Color fundus photograph, 2352x1568px, 45° FOV: 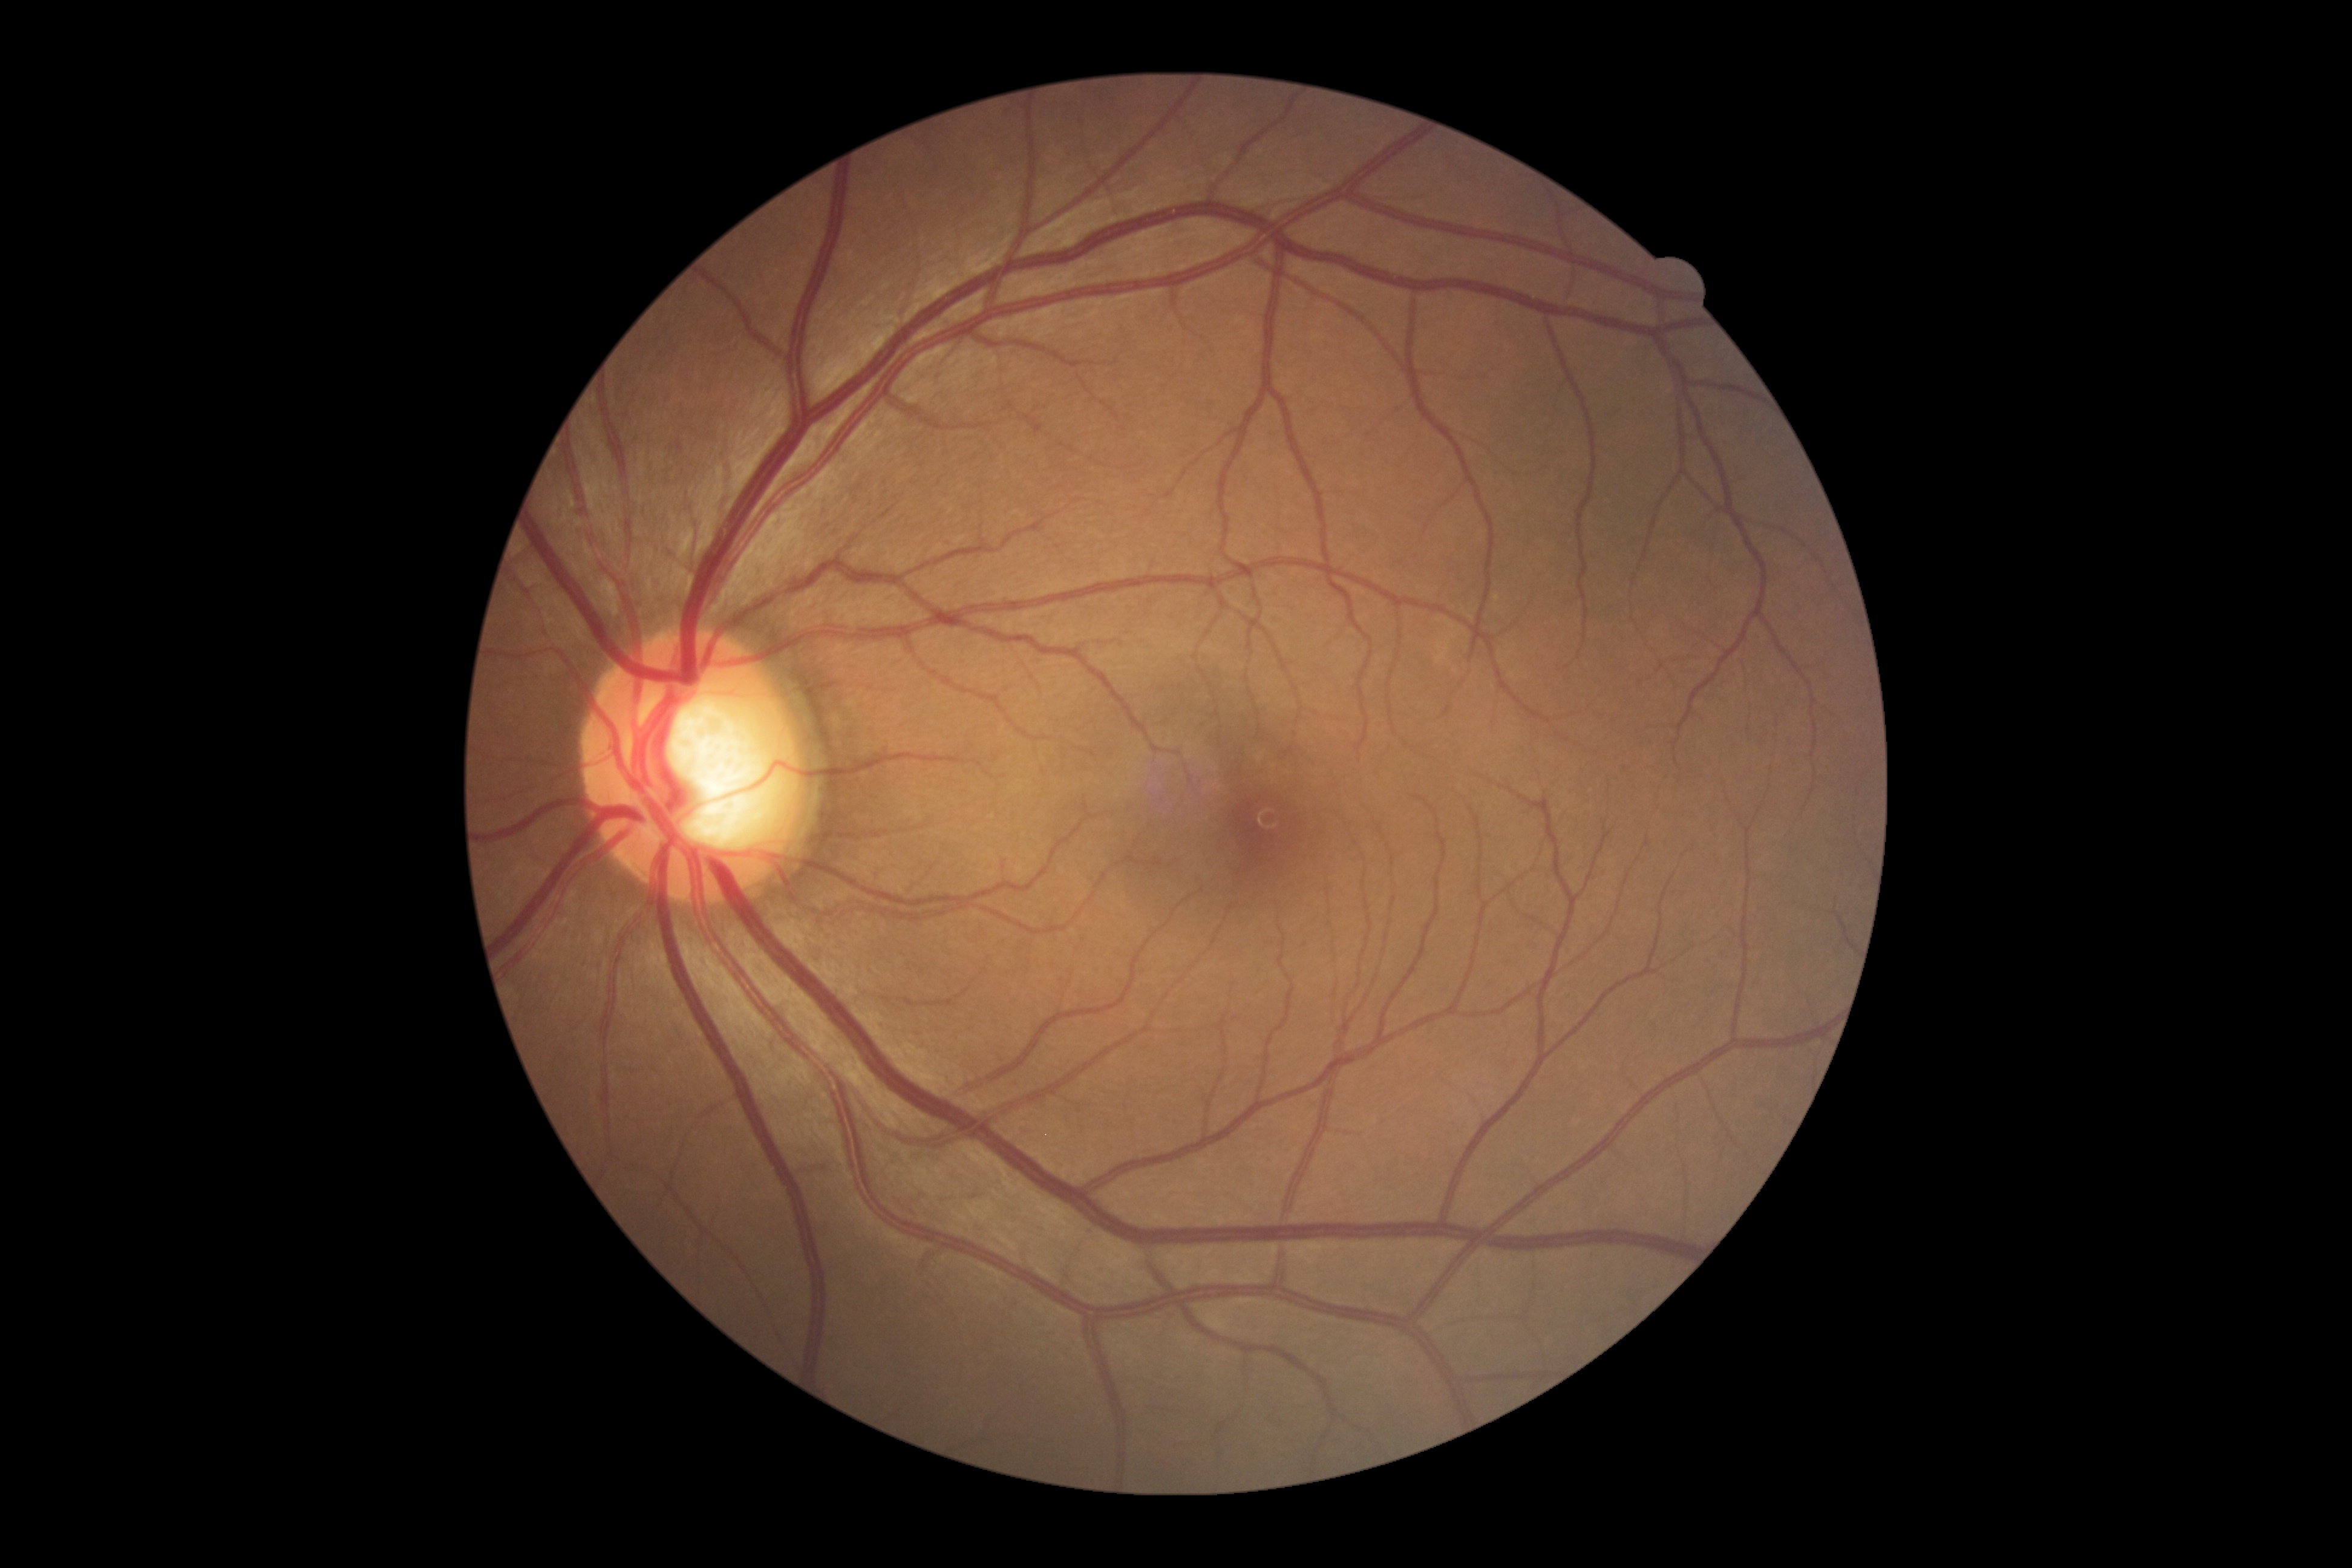 DR stage: grade 0 (no apparent retinopathy). No DR findings.